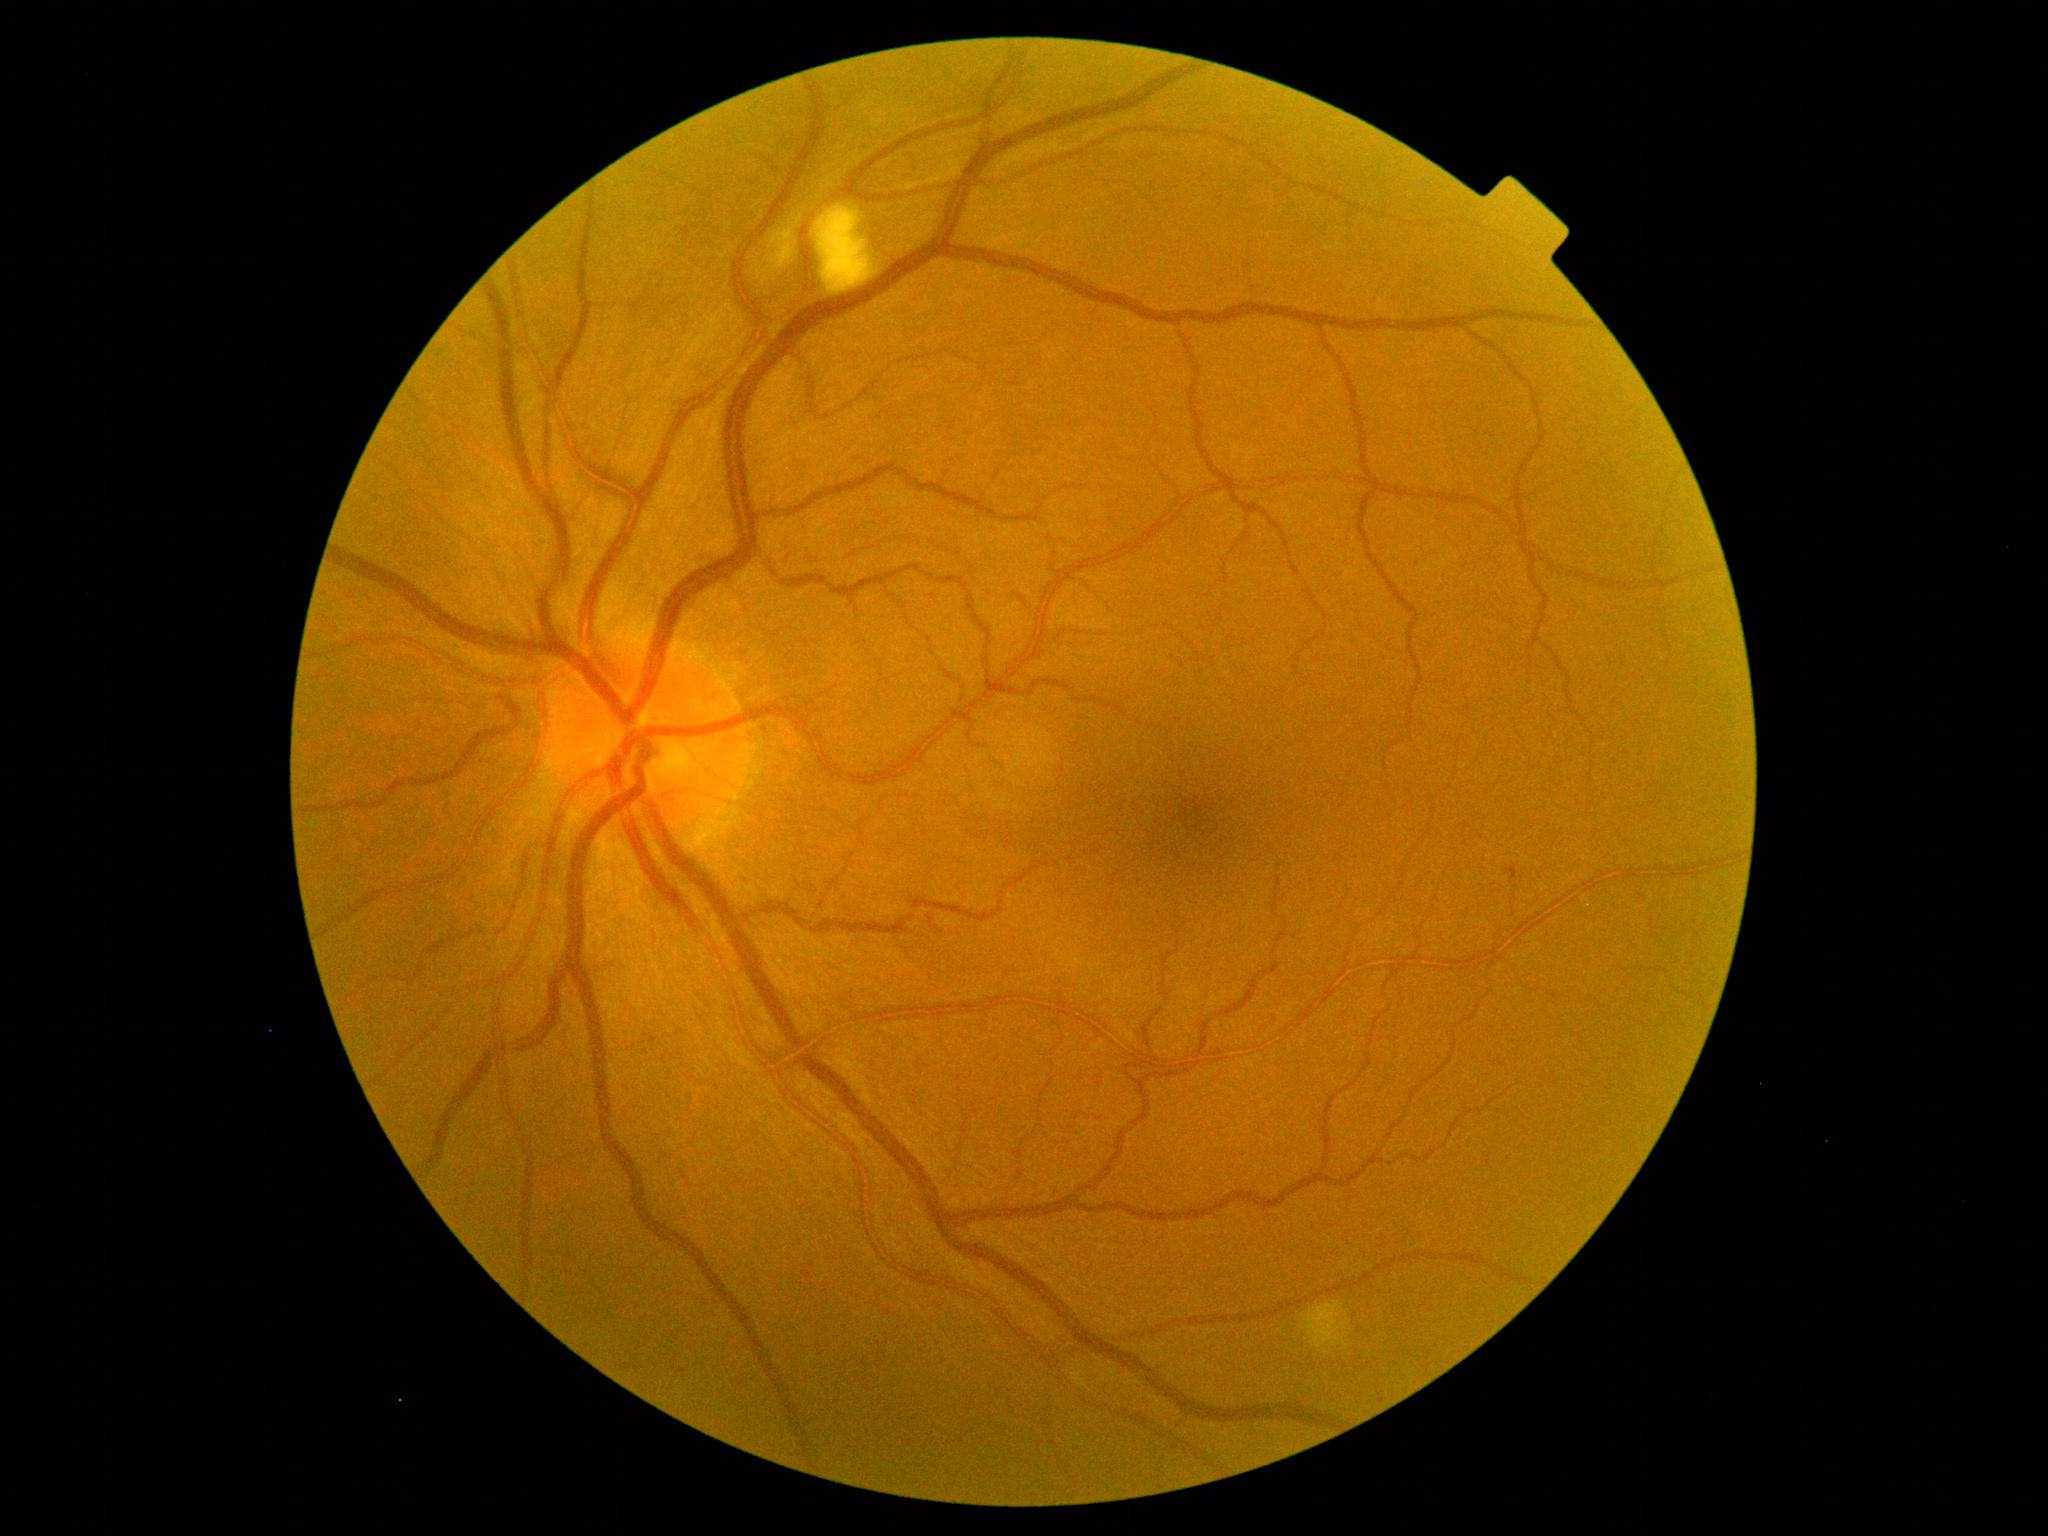

DR grade is 2.